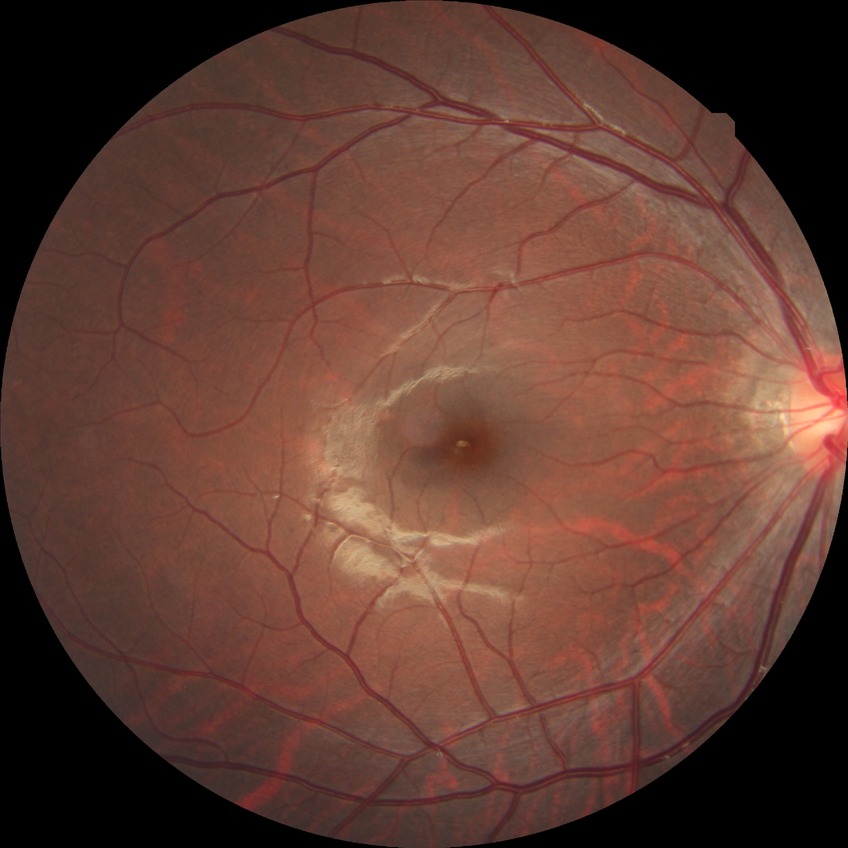 diabetic retinopathy severity: no diabetic retinopathy.